NIDEK AFC-230 · nonmydriatic fundus photograph
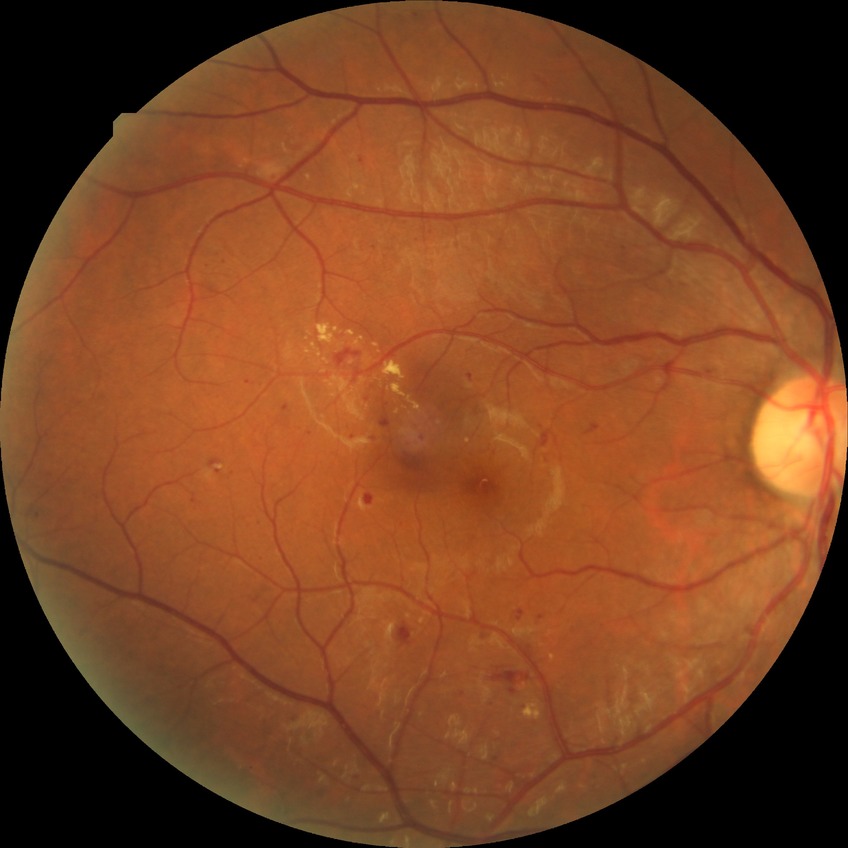

DR class: non-proliferative diabetic retinopathy. Modified Davis classification: simple diabetic retinopathy.